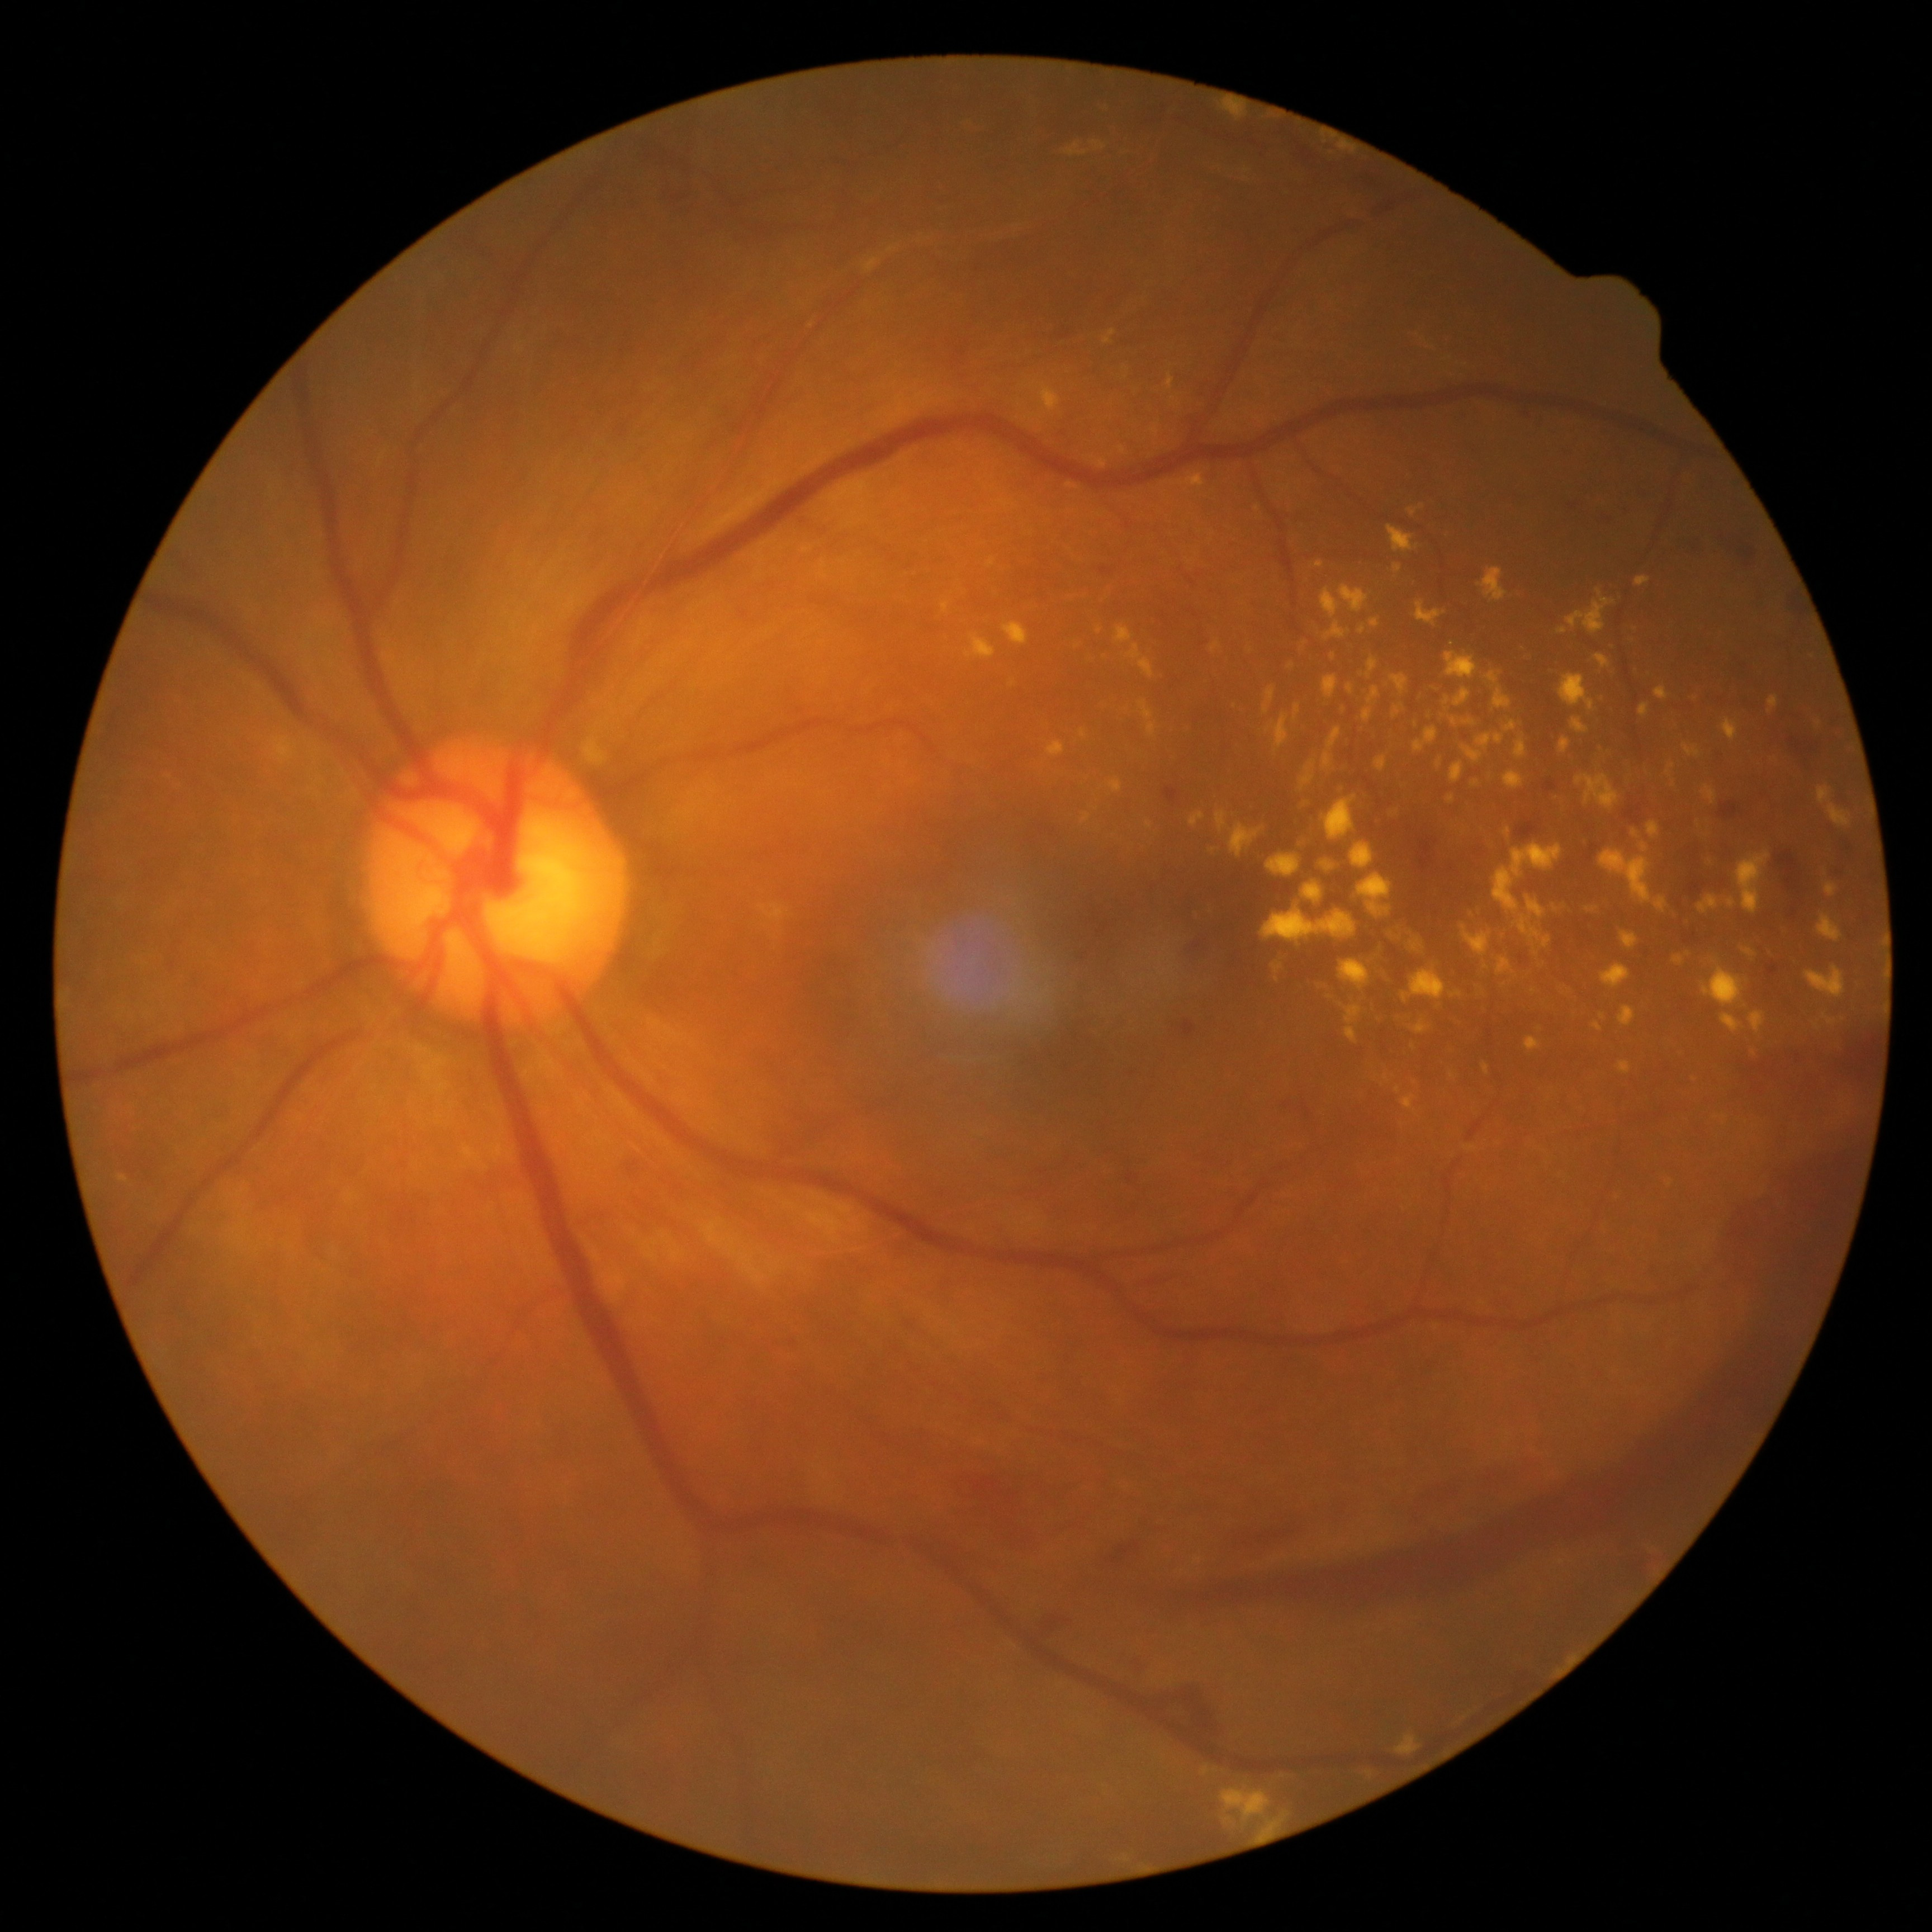

DR stage: 4/4 — neovascularization and/or vitreous/pre-retinal hemorrhage. EXs are present, including at x1=1395 y1=564 x2=1401 y2=573; x1=1448 y1=991 x2=1463 y2=999; x1=1393 y1=706 x2=1400 y2=718; x1=1585 y1=907 x2=1598 y2=913; x1=1817 y1=914 x2=1842 y2=941; x1=1341 y1=949 x2=1389 y2=990; x1=1806 y1=967 x2=1846 y2=999; x1=1702 y1=785 x2=1717 y2=803; x1=1622 y1=932 x2=1640 y2=951; x1=1620 y1=1062 x2=1632 y2=1074; x1=1655 y1=686 x2=1670 y2=700; x1=1217 y1=812 x2=1227 y2=831; x1=1387 y1=526 x2=1419 y2=553; x1=1461 y1=745 x2=1483 y2=763; x1=1552 y1=905 x2=1558 y2=913; x1=1395 y1=1011 x2=1416 y2=1026; x1=1274 y1=713 x2=1289 y2=749. Small EXs near point(1453, 1076); point(1257, 509).